Camera: NIDEK AFC-230:
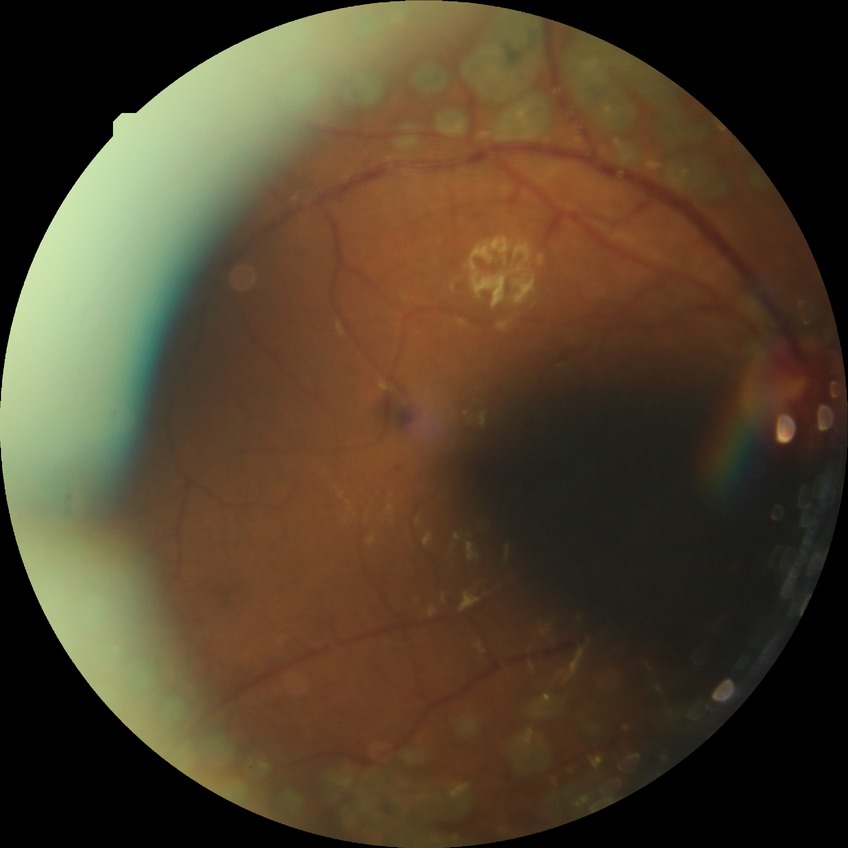 DR is PDR.